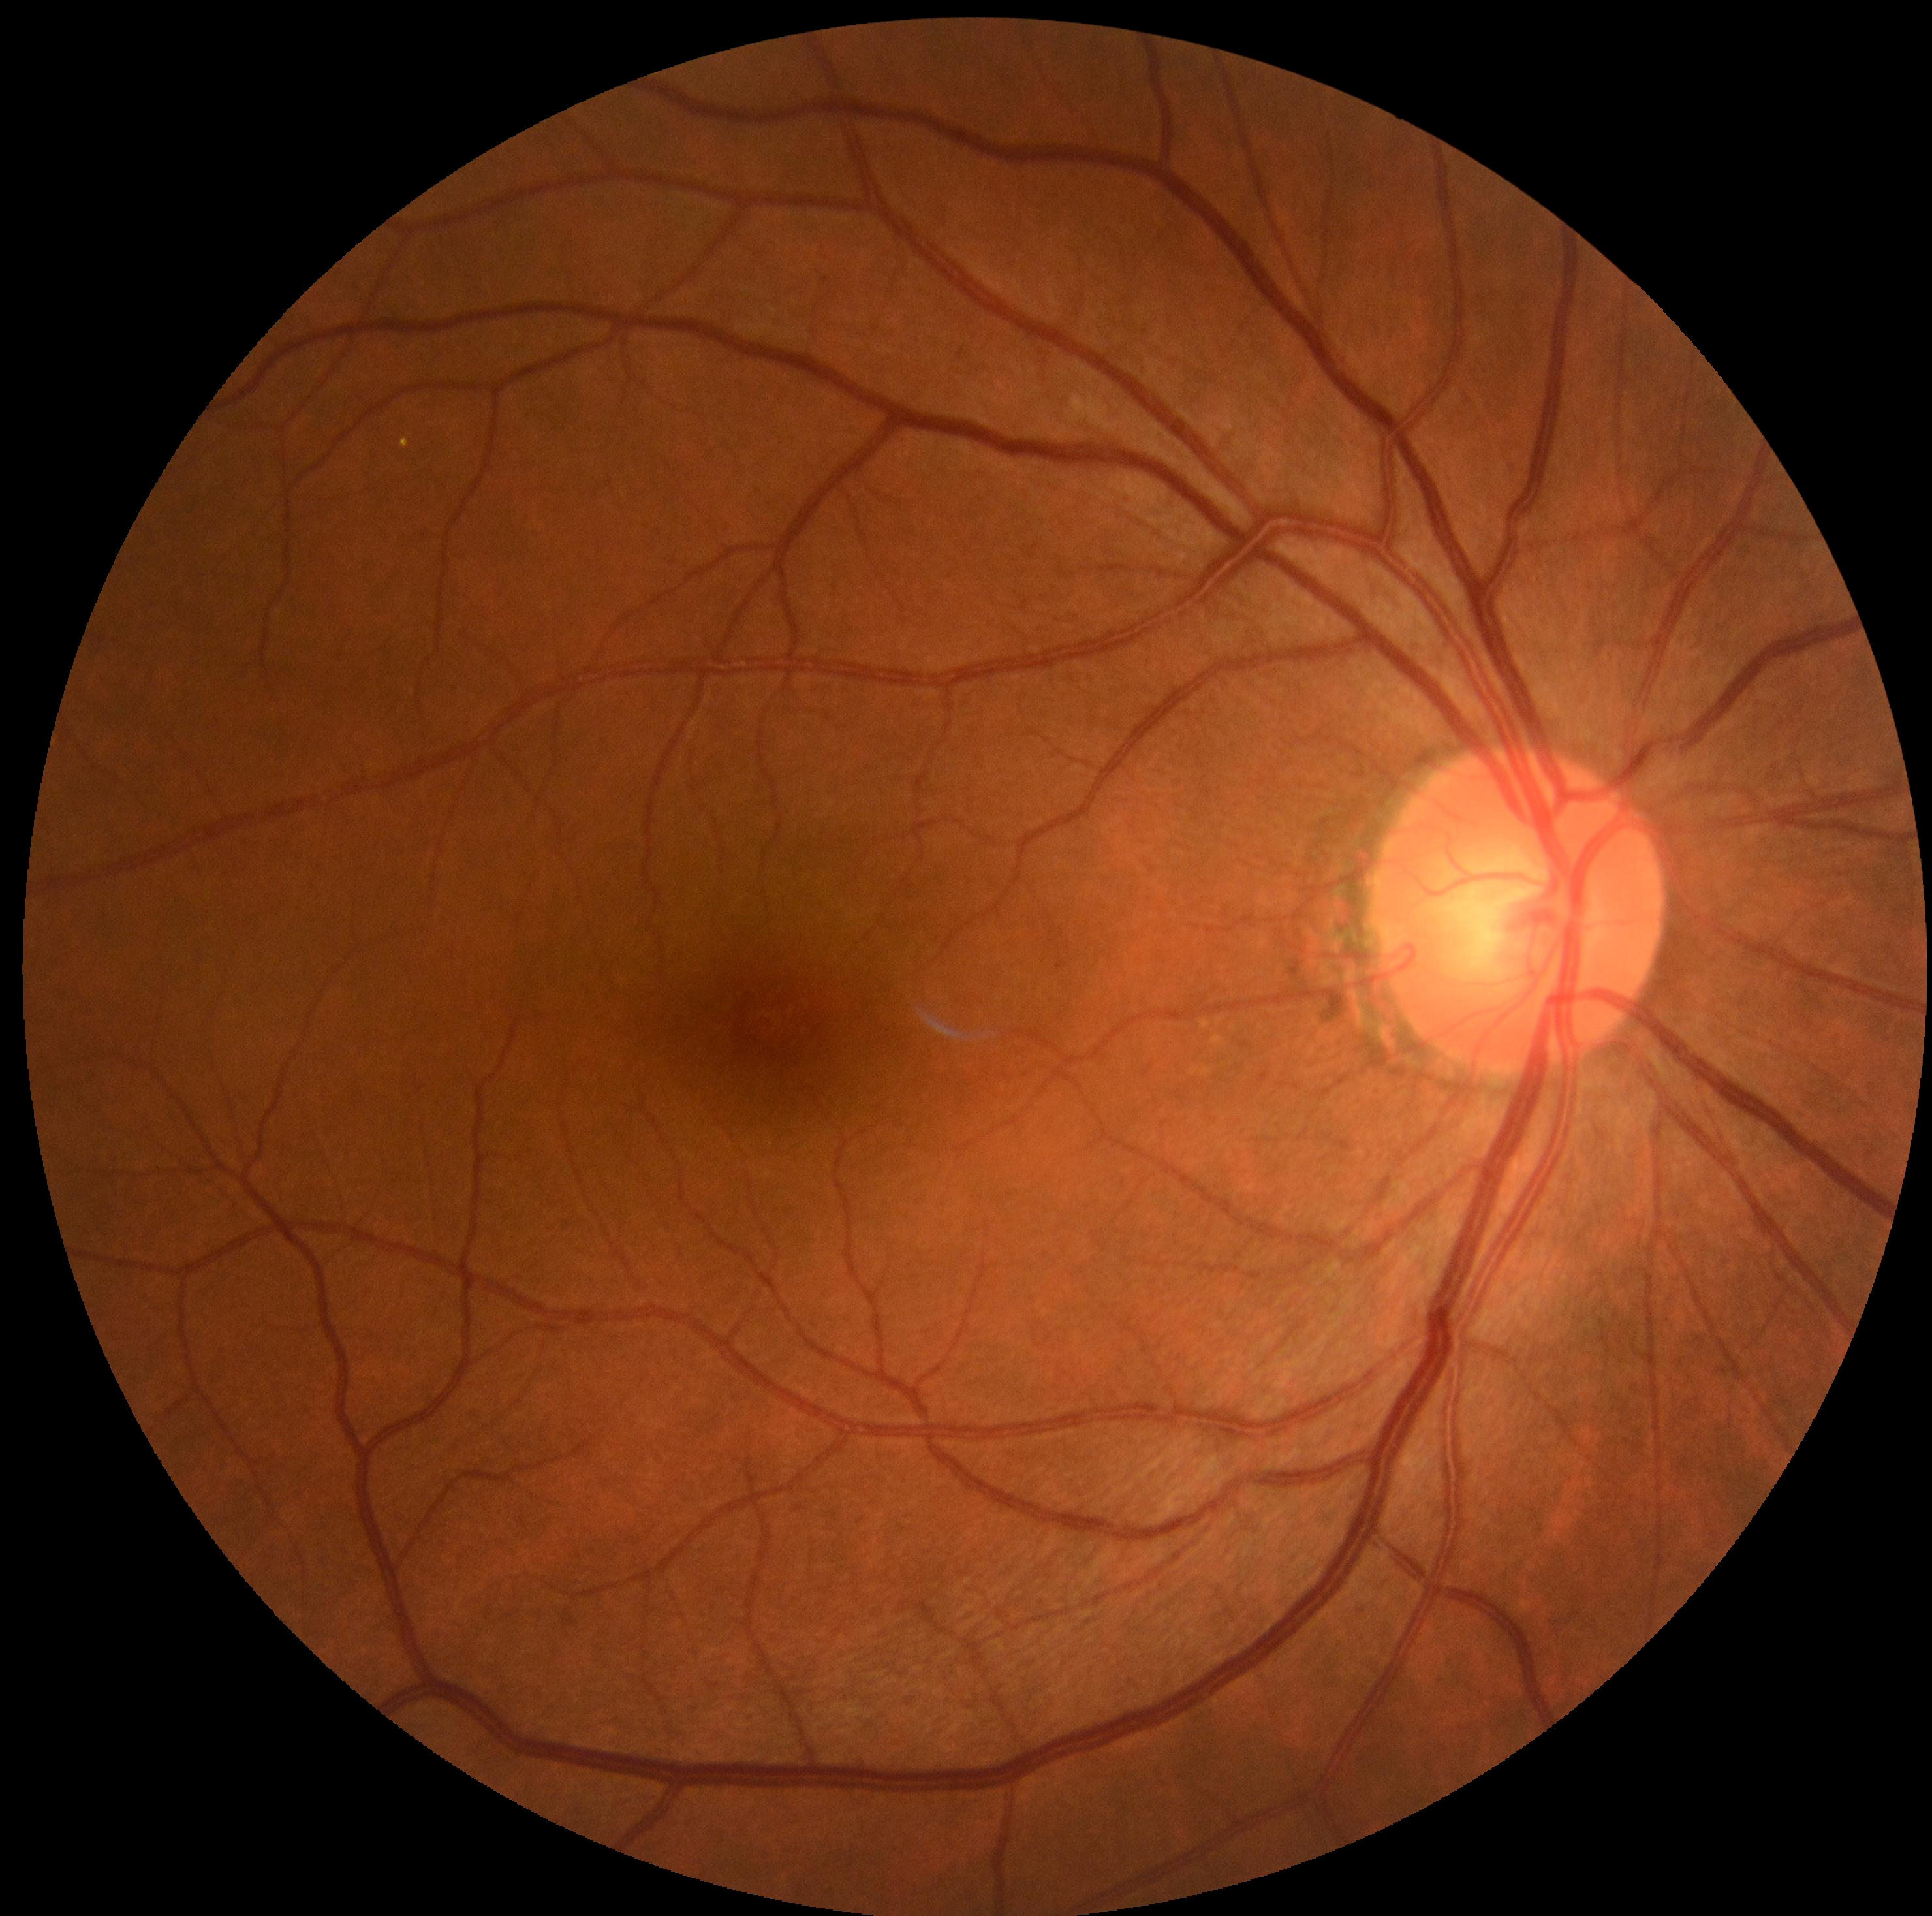 No diabetic retinal disease findings.
Diabetic retinopathy severity: no apparent diabetic retinopathy (grade 0).